30-degree field of view; patient age: 53 years; non-mydriatic; pachymetry: 529 µm; 2212 x 1661 pixels.
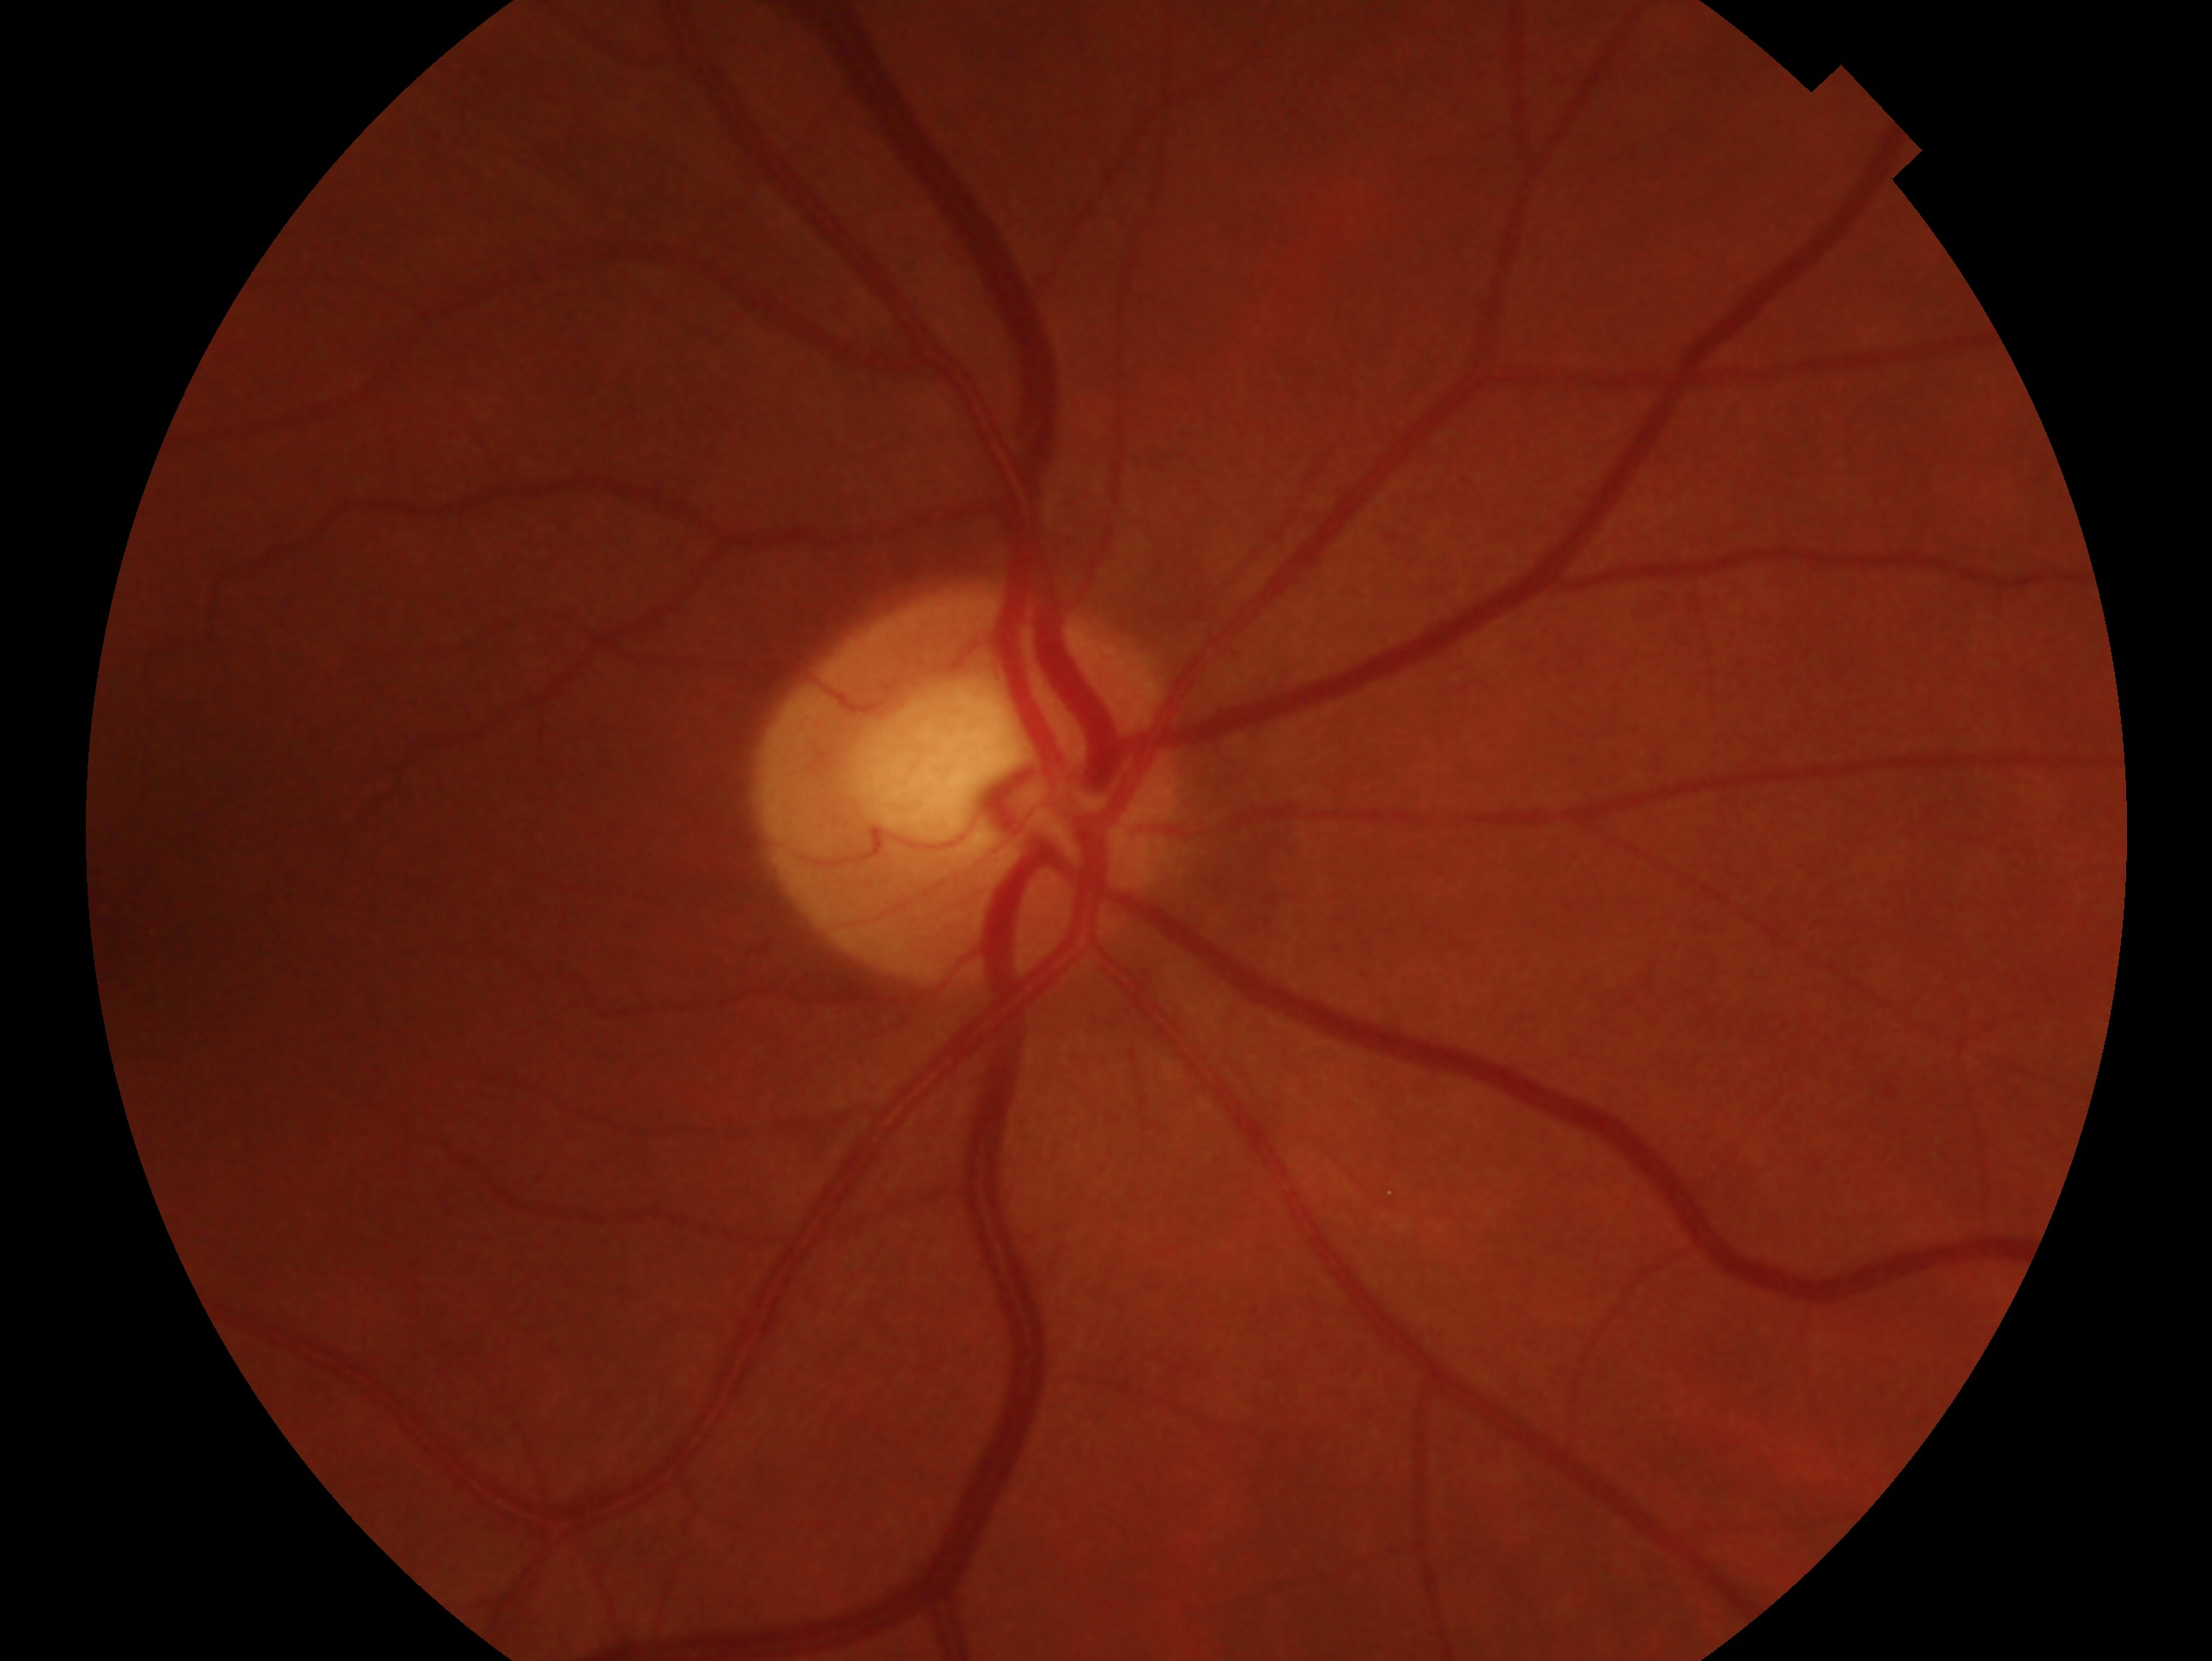 Annotations:
– glaucoma assessment — possible glaucoma
– laterality — right eye